No pharmacologic dilation · FOV: 45 degrees · modified Davis grading: 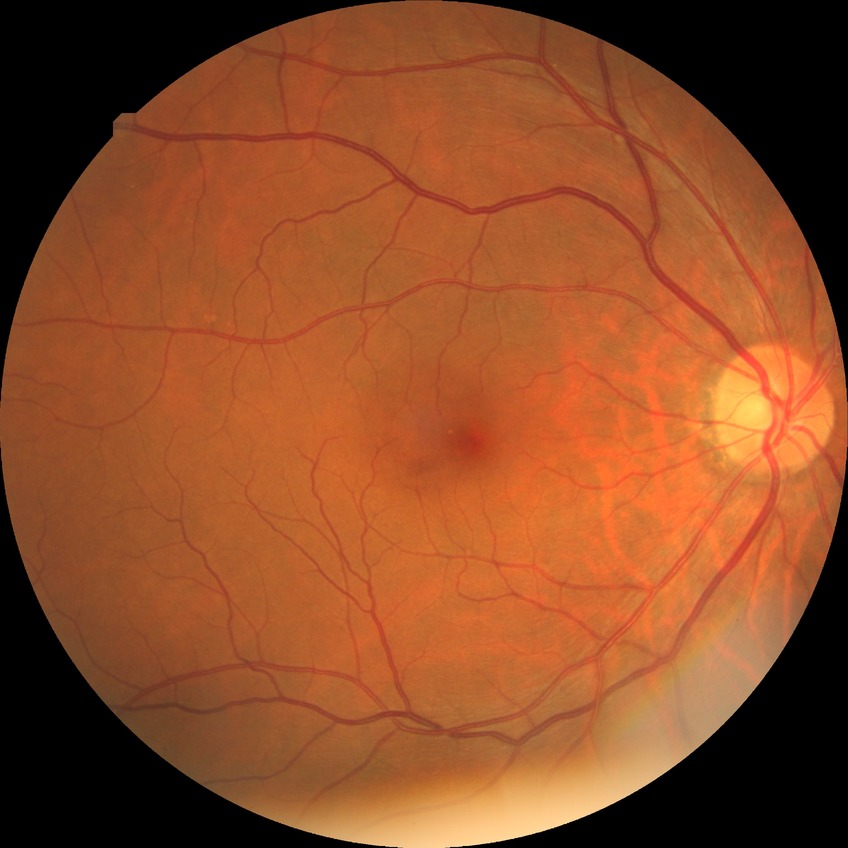
davis_grade: NDR (no diabetic retinopathy)